DR severity per modified Davis staging: 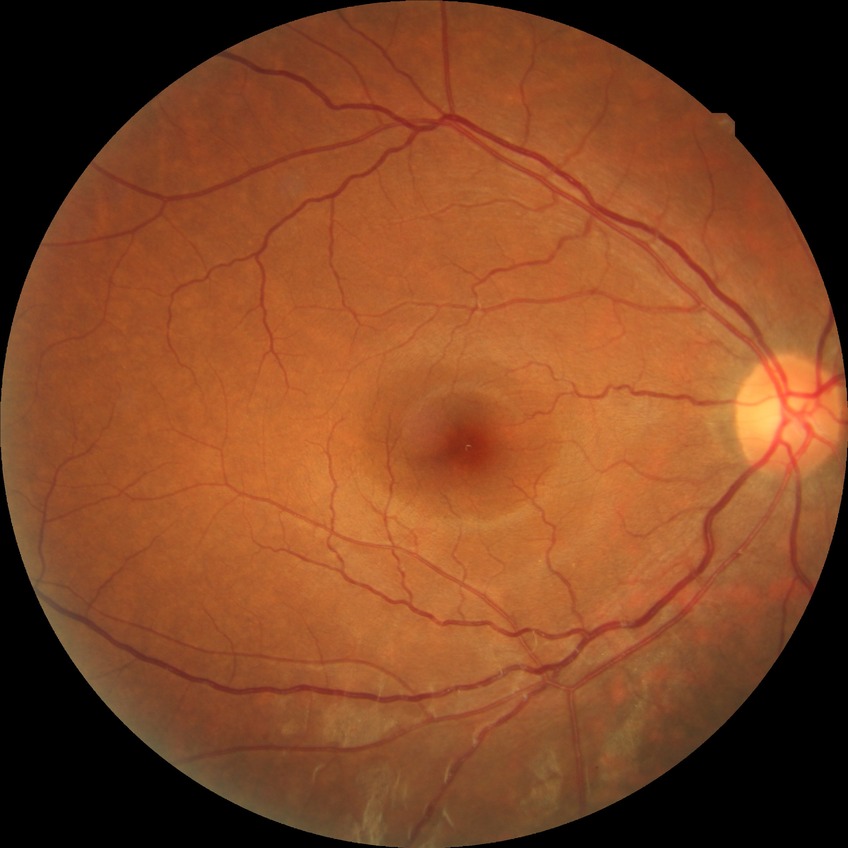 Davis grading: no diabetic retinopathy.